2048 x 1536 pixels. 45° FOV
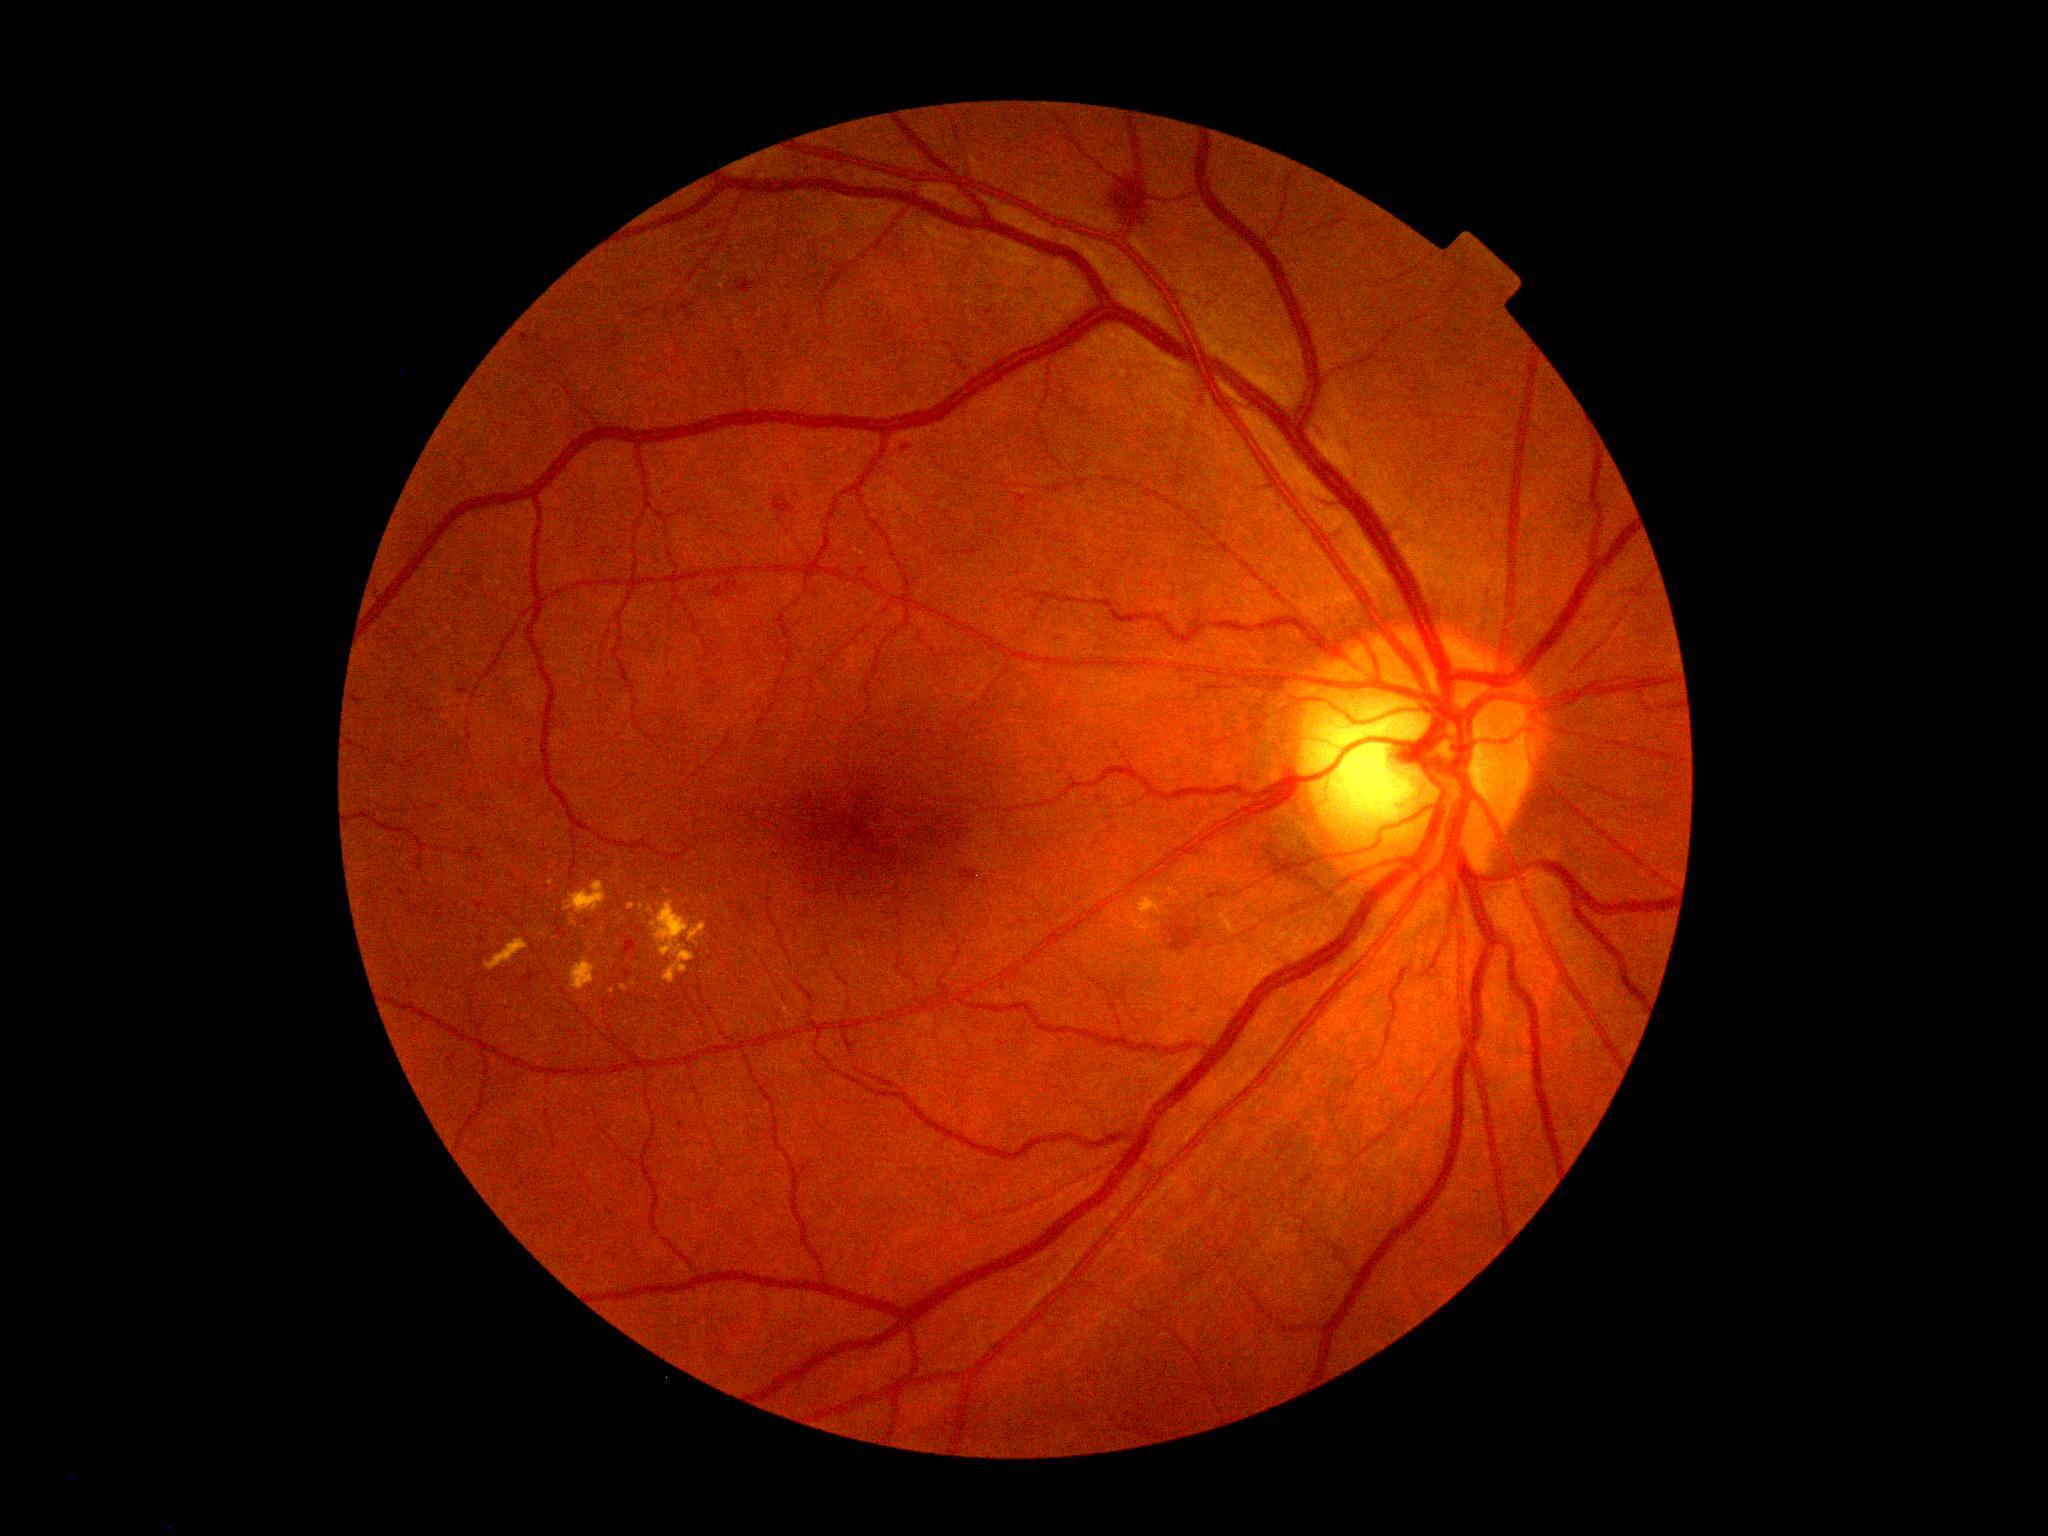 Diabetic retinopathy (DR) is moderate non-proliferative diabetic retinopathy (grade 2).